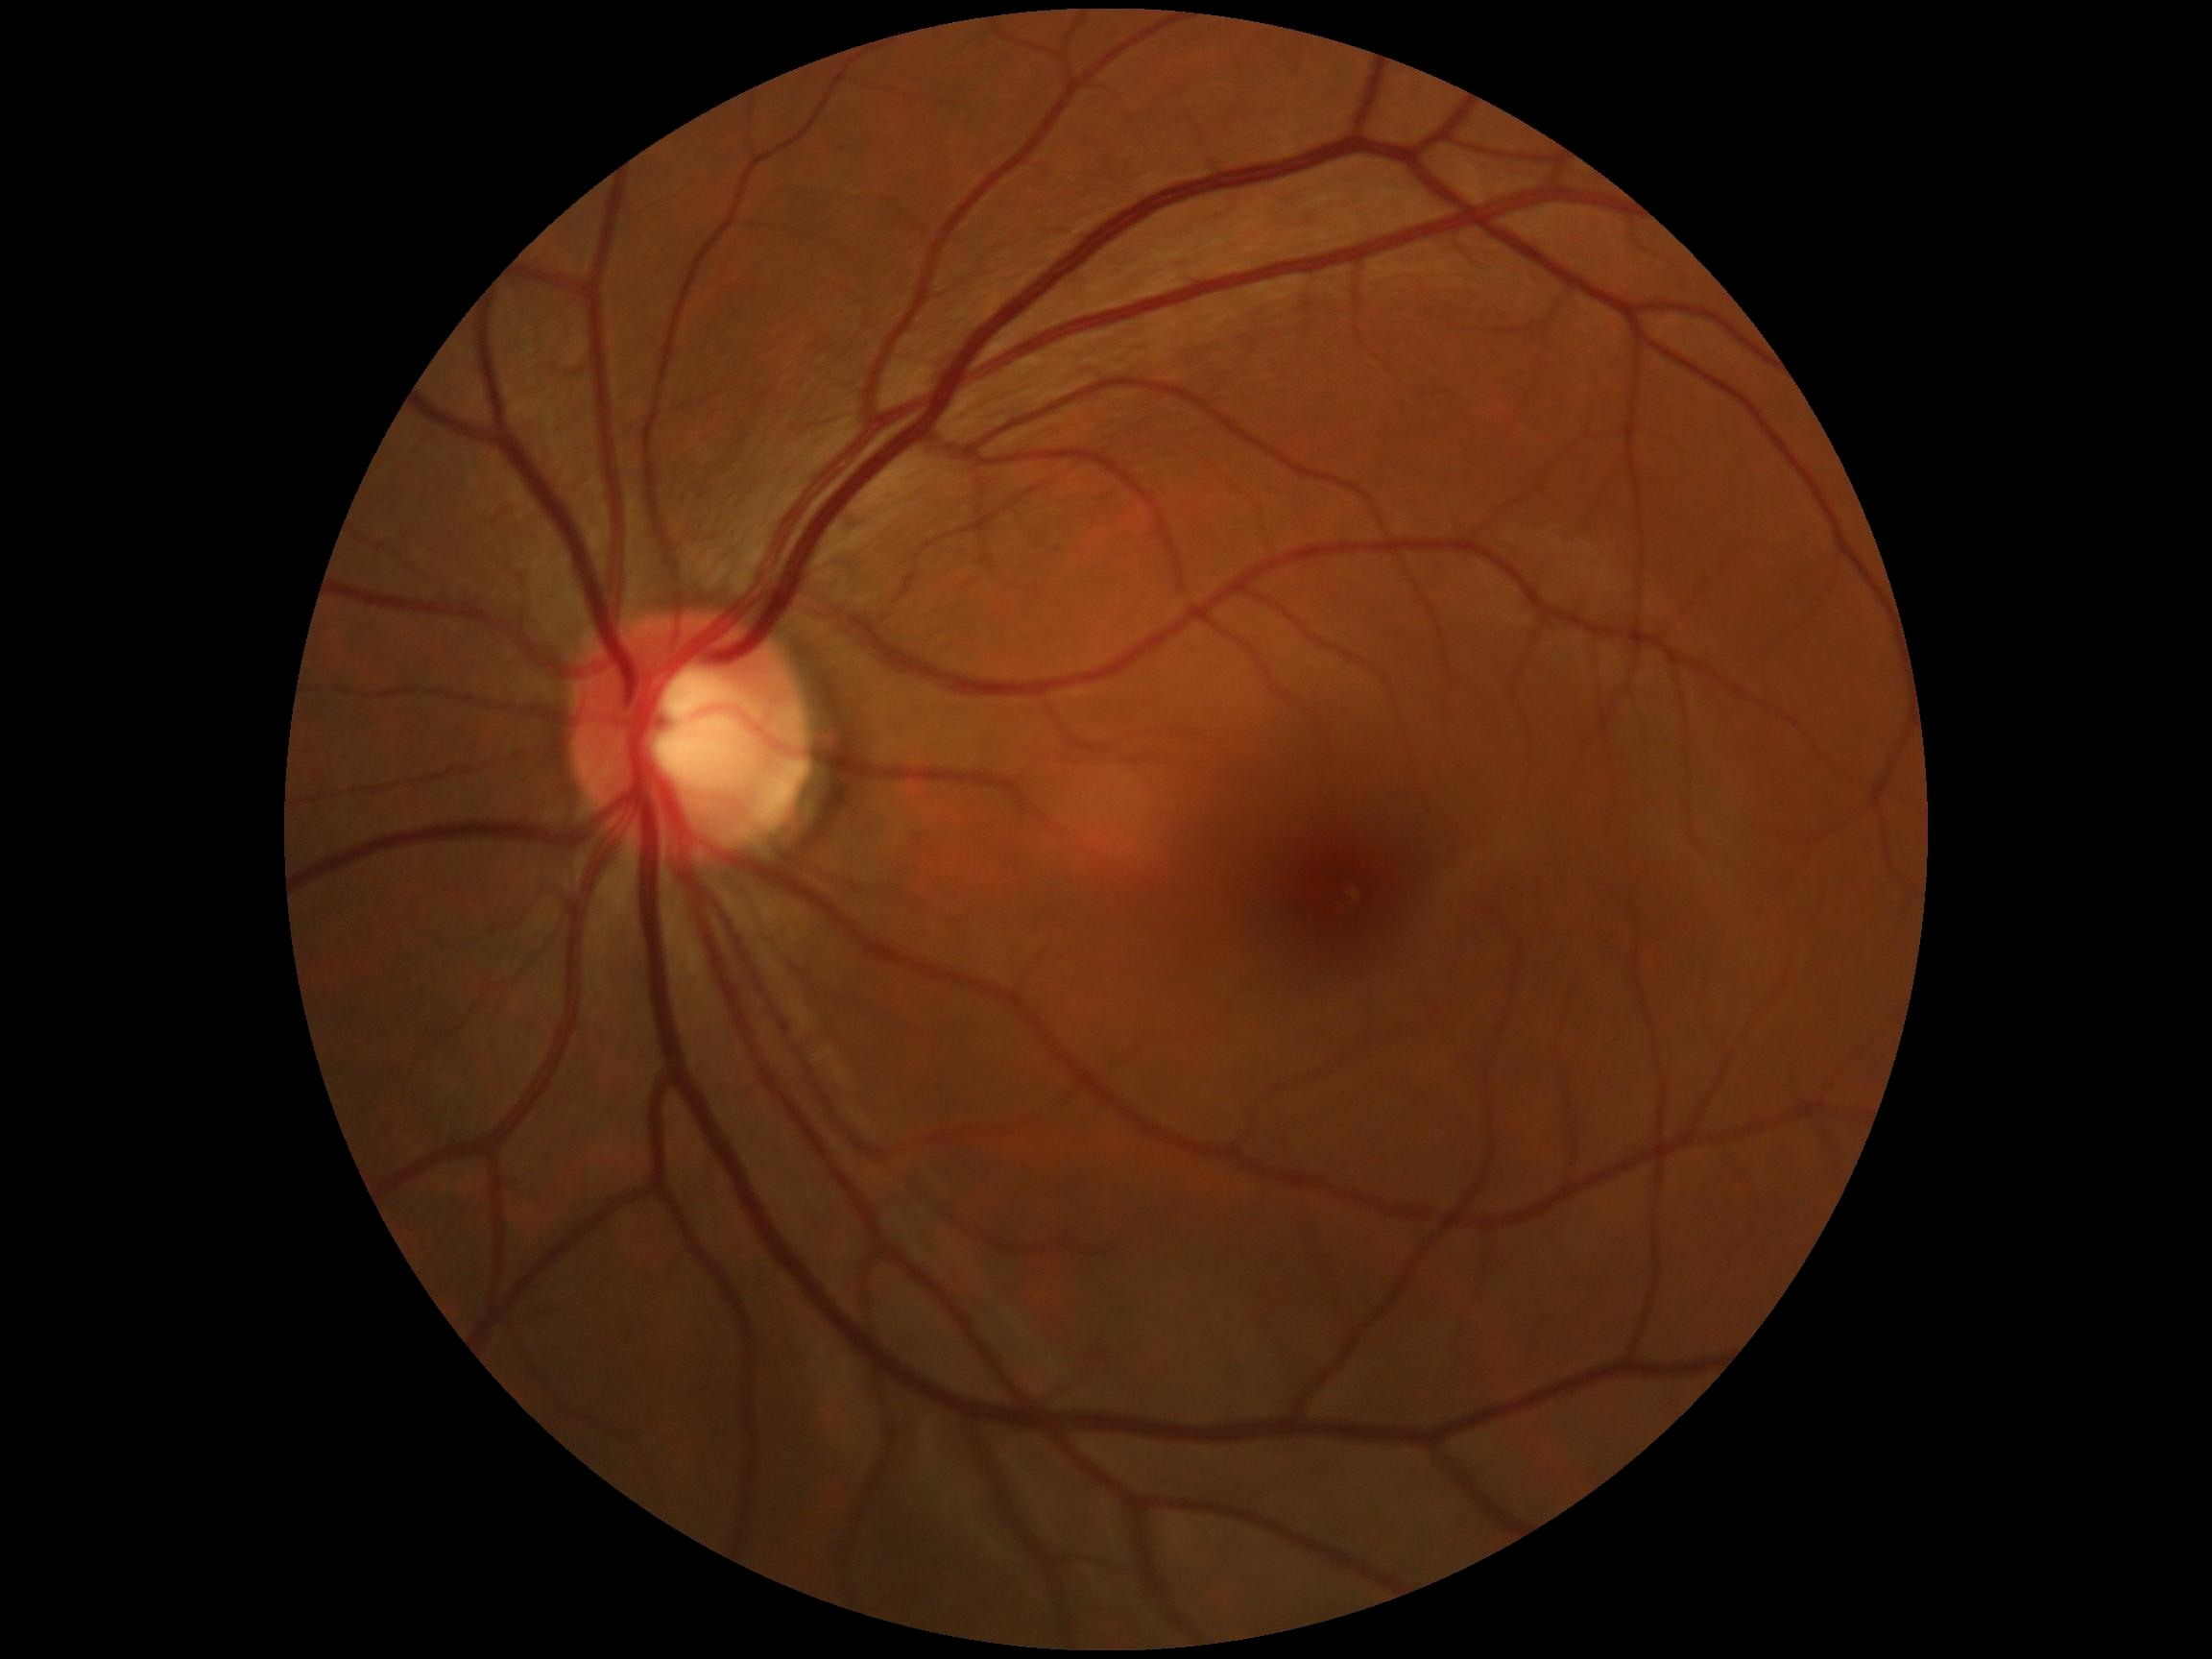
Diabetic retinopathy (DR) is no apparent diabetic retinopathy (grade 0).